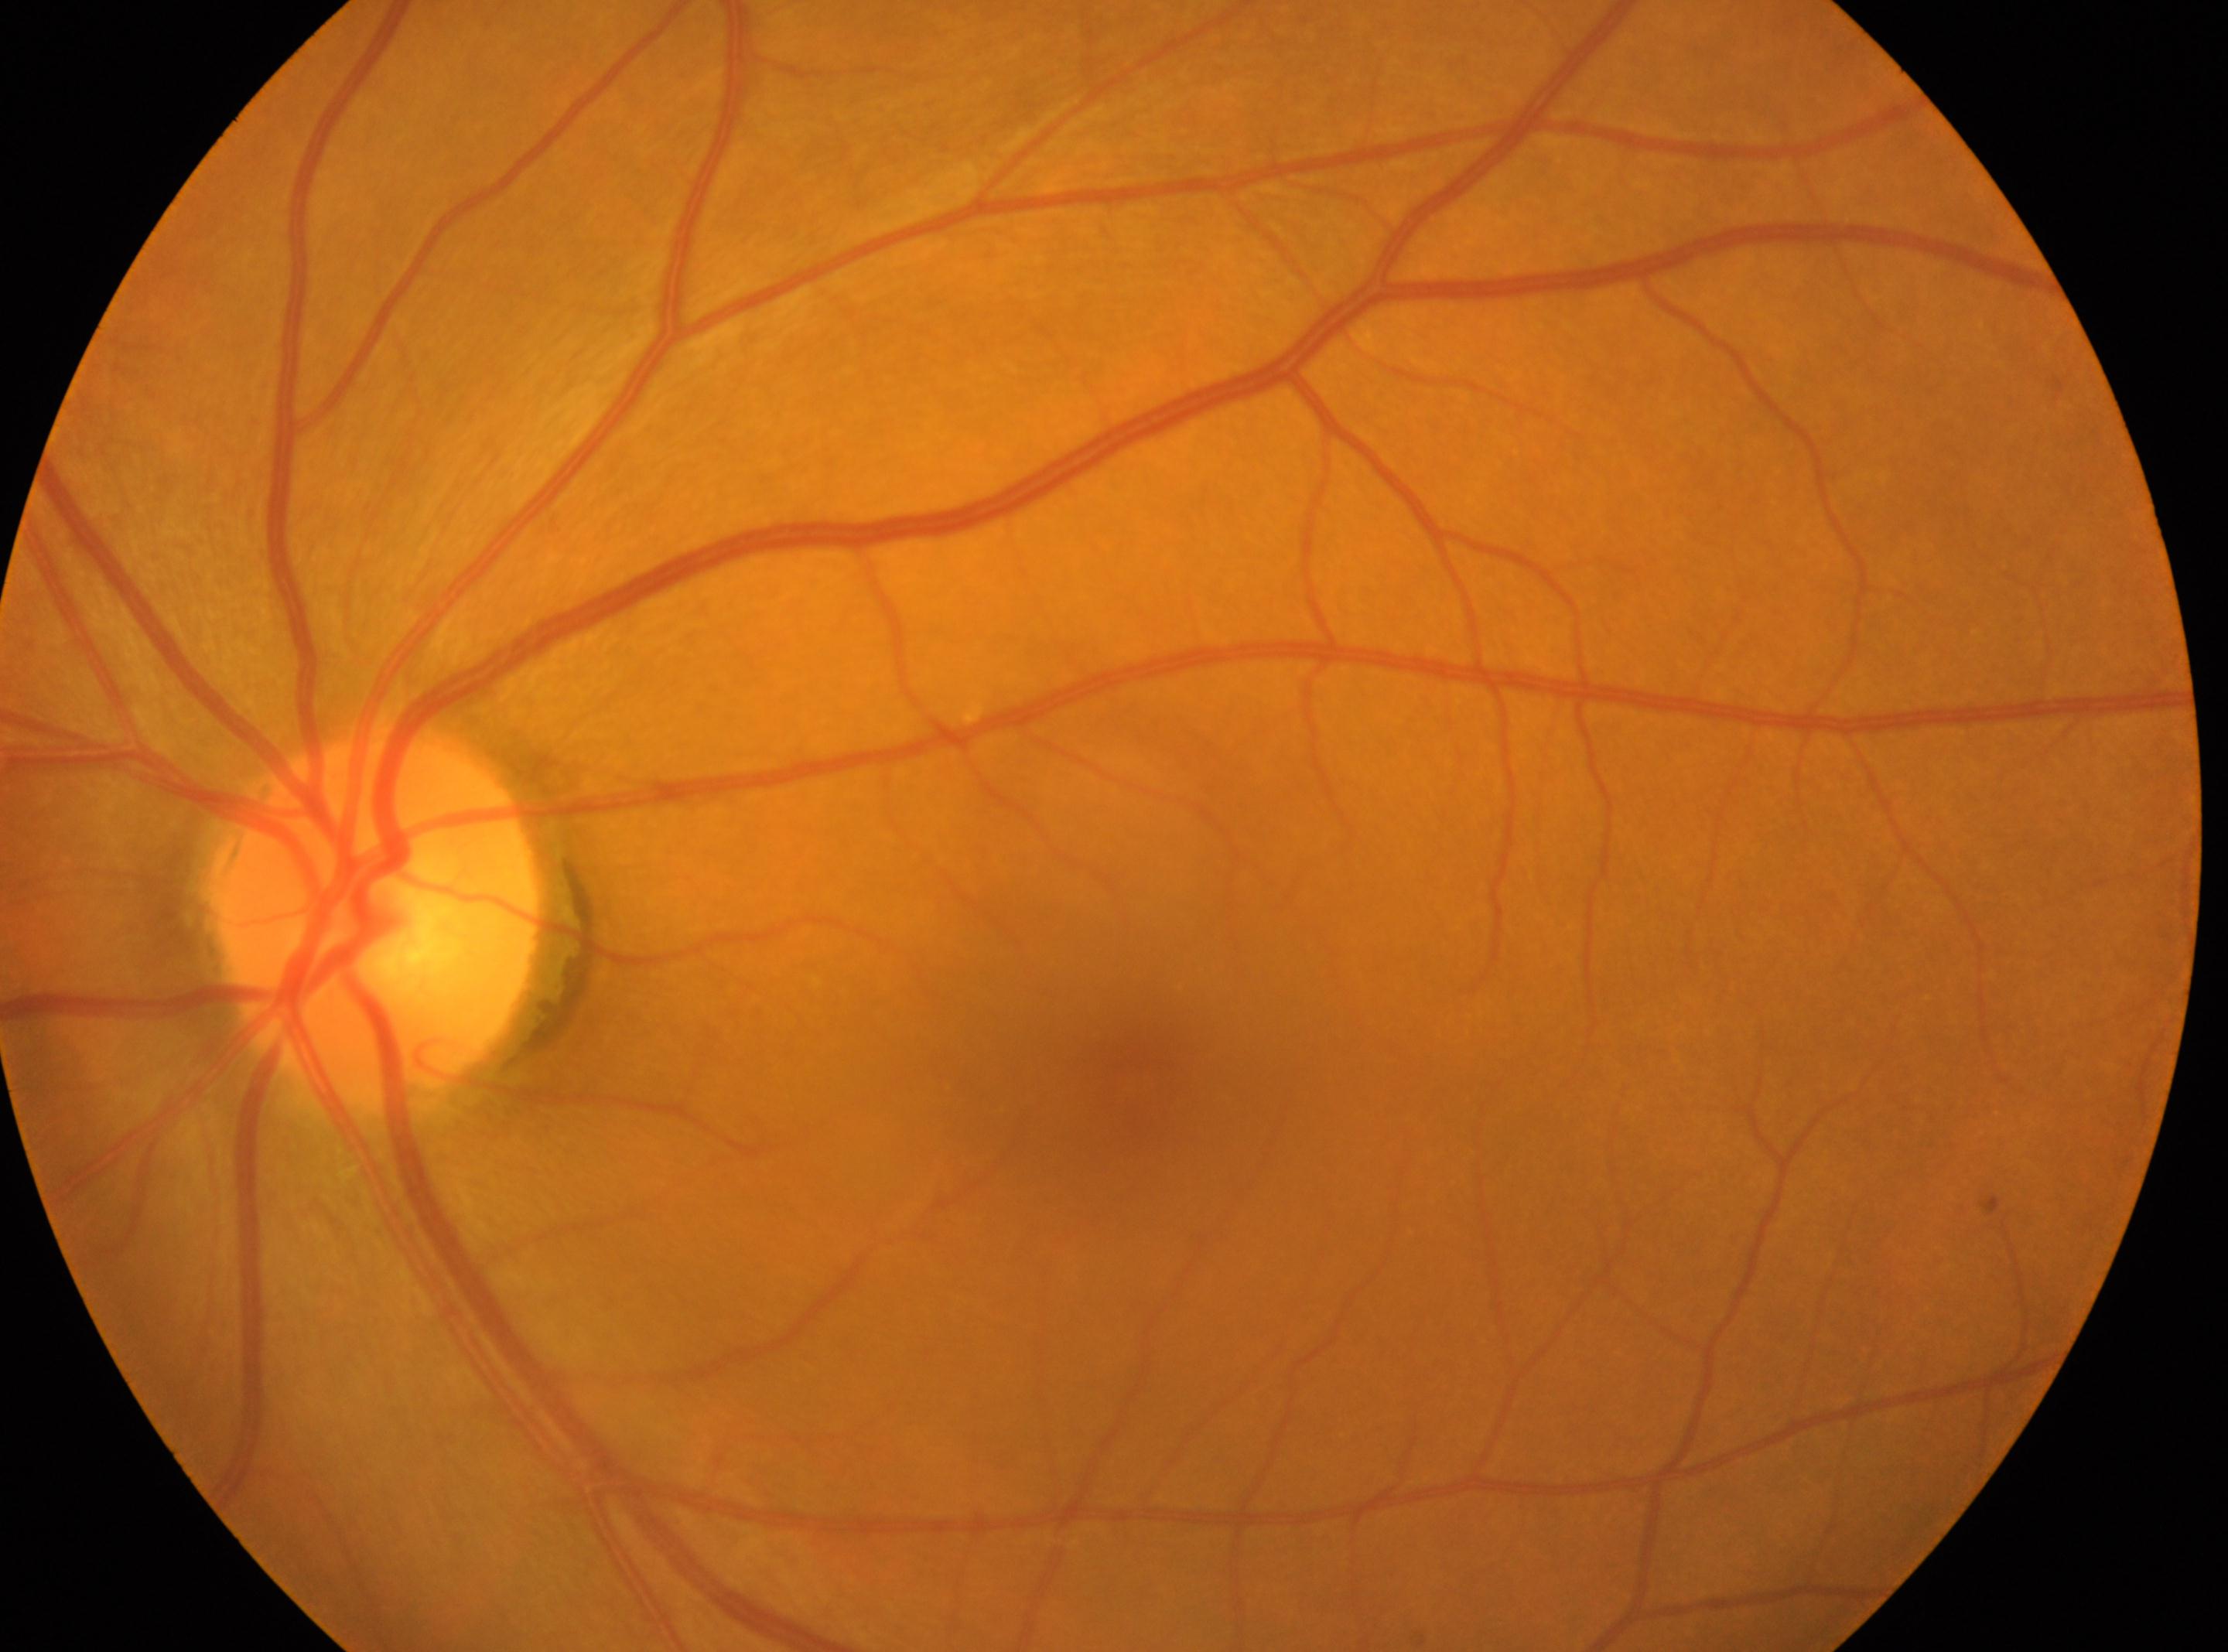 diabetic retinopathy severity = grade 0 — no visible signs of diabetic retinopathy
laterality = oculus sinister
macular center = [1131, 1081]
optic disc center = [373, 916]
DR impression = No signs of diabetic retinopathy